848 x 848 pixels
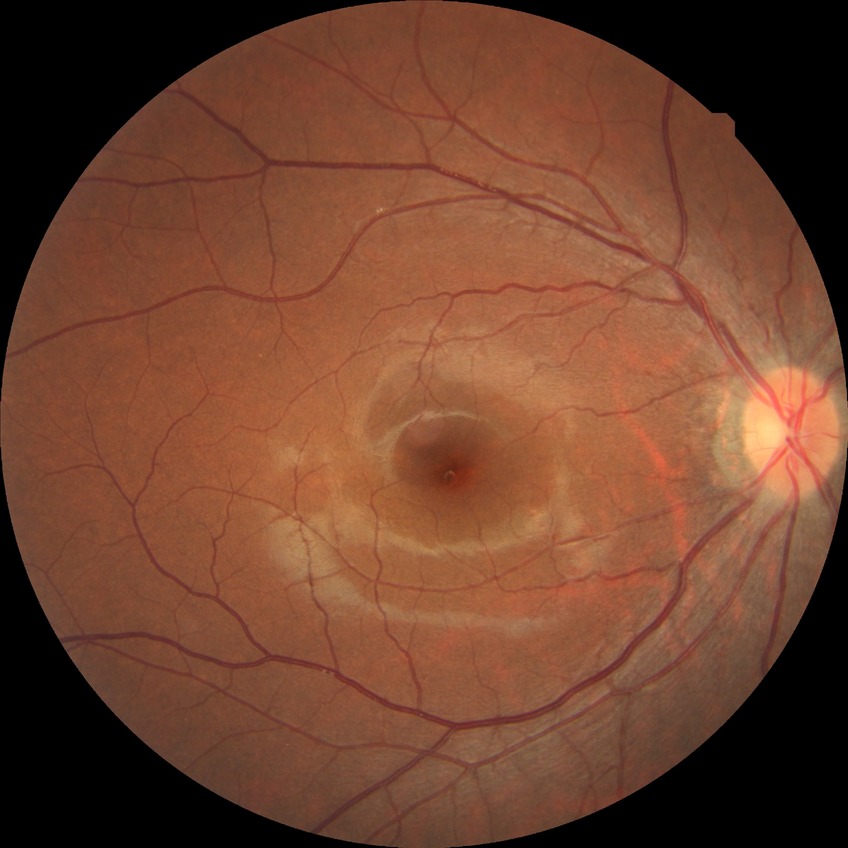

Diabetic retinopathy (DR) is NDR (no diabetic retinopathy).